2228 x 1652 pixels · color fundus photograph
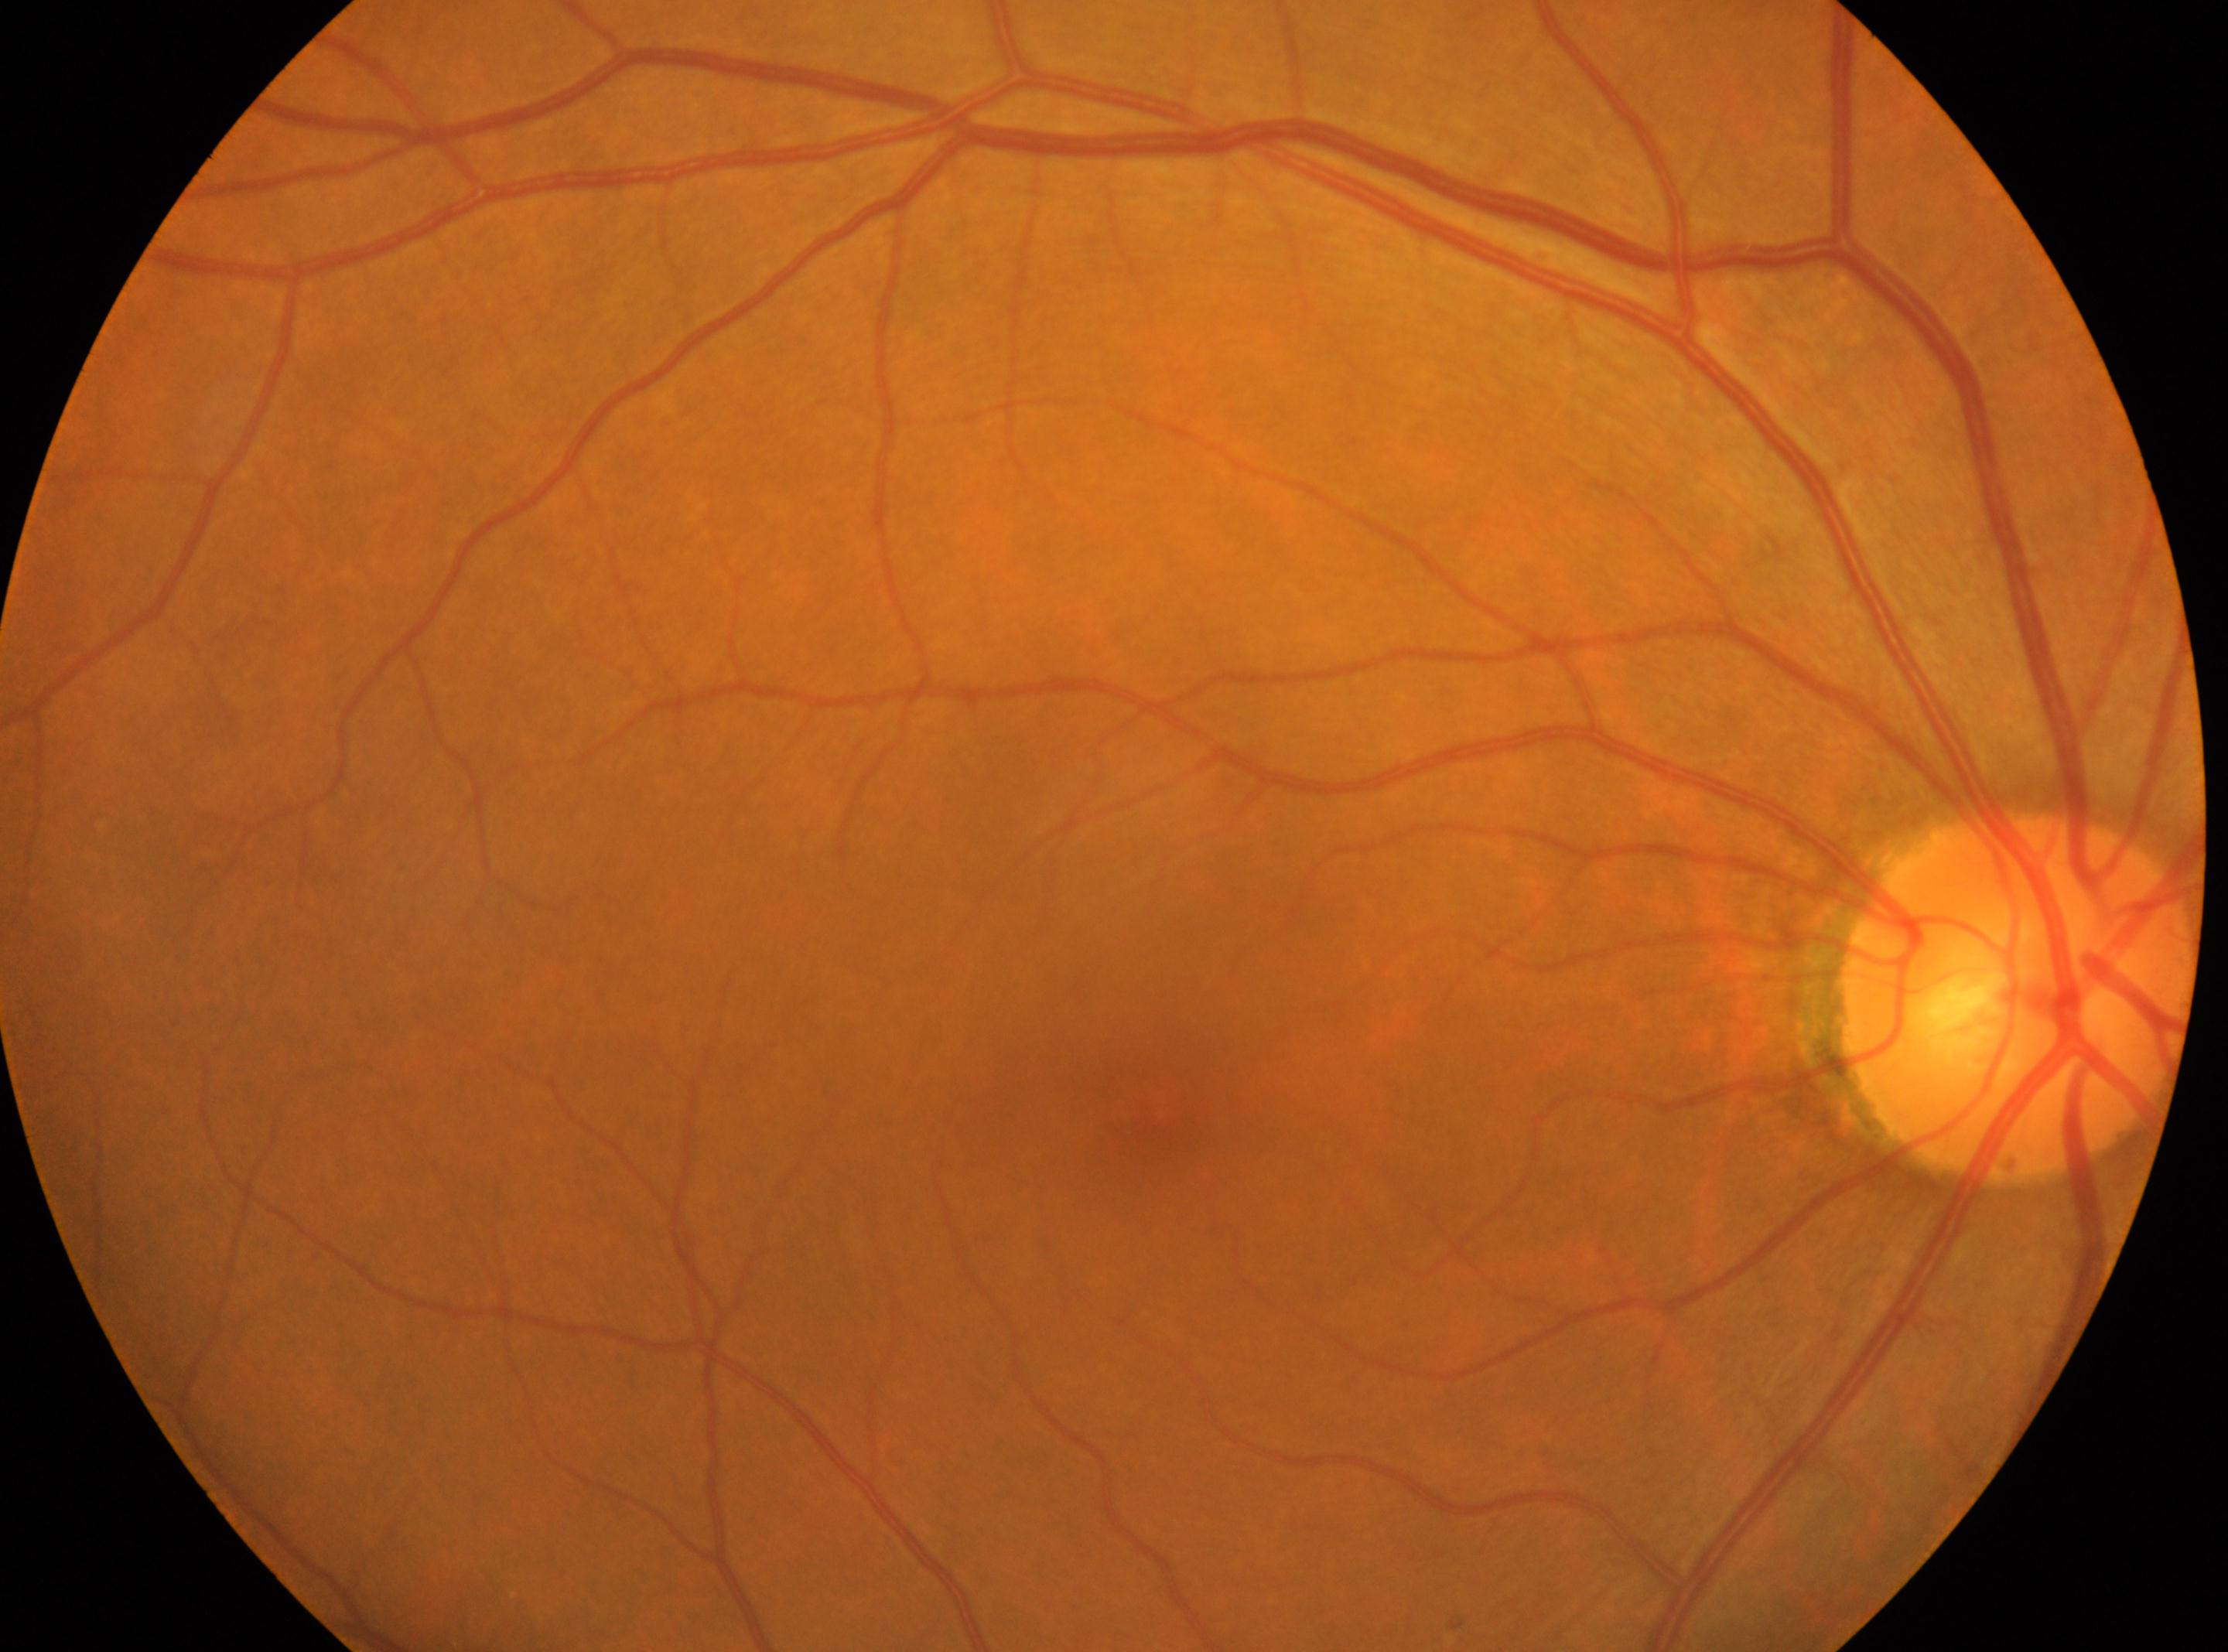
Optic nerve head located at (x: 2015, y: 1000). Eye: OD. Retinopathy: 0/4. Macular center: (x: 1154, y: 1106).